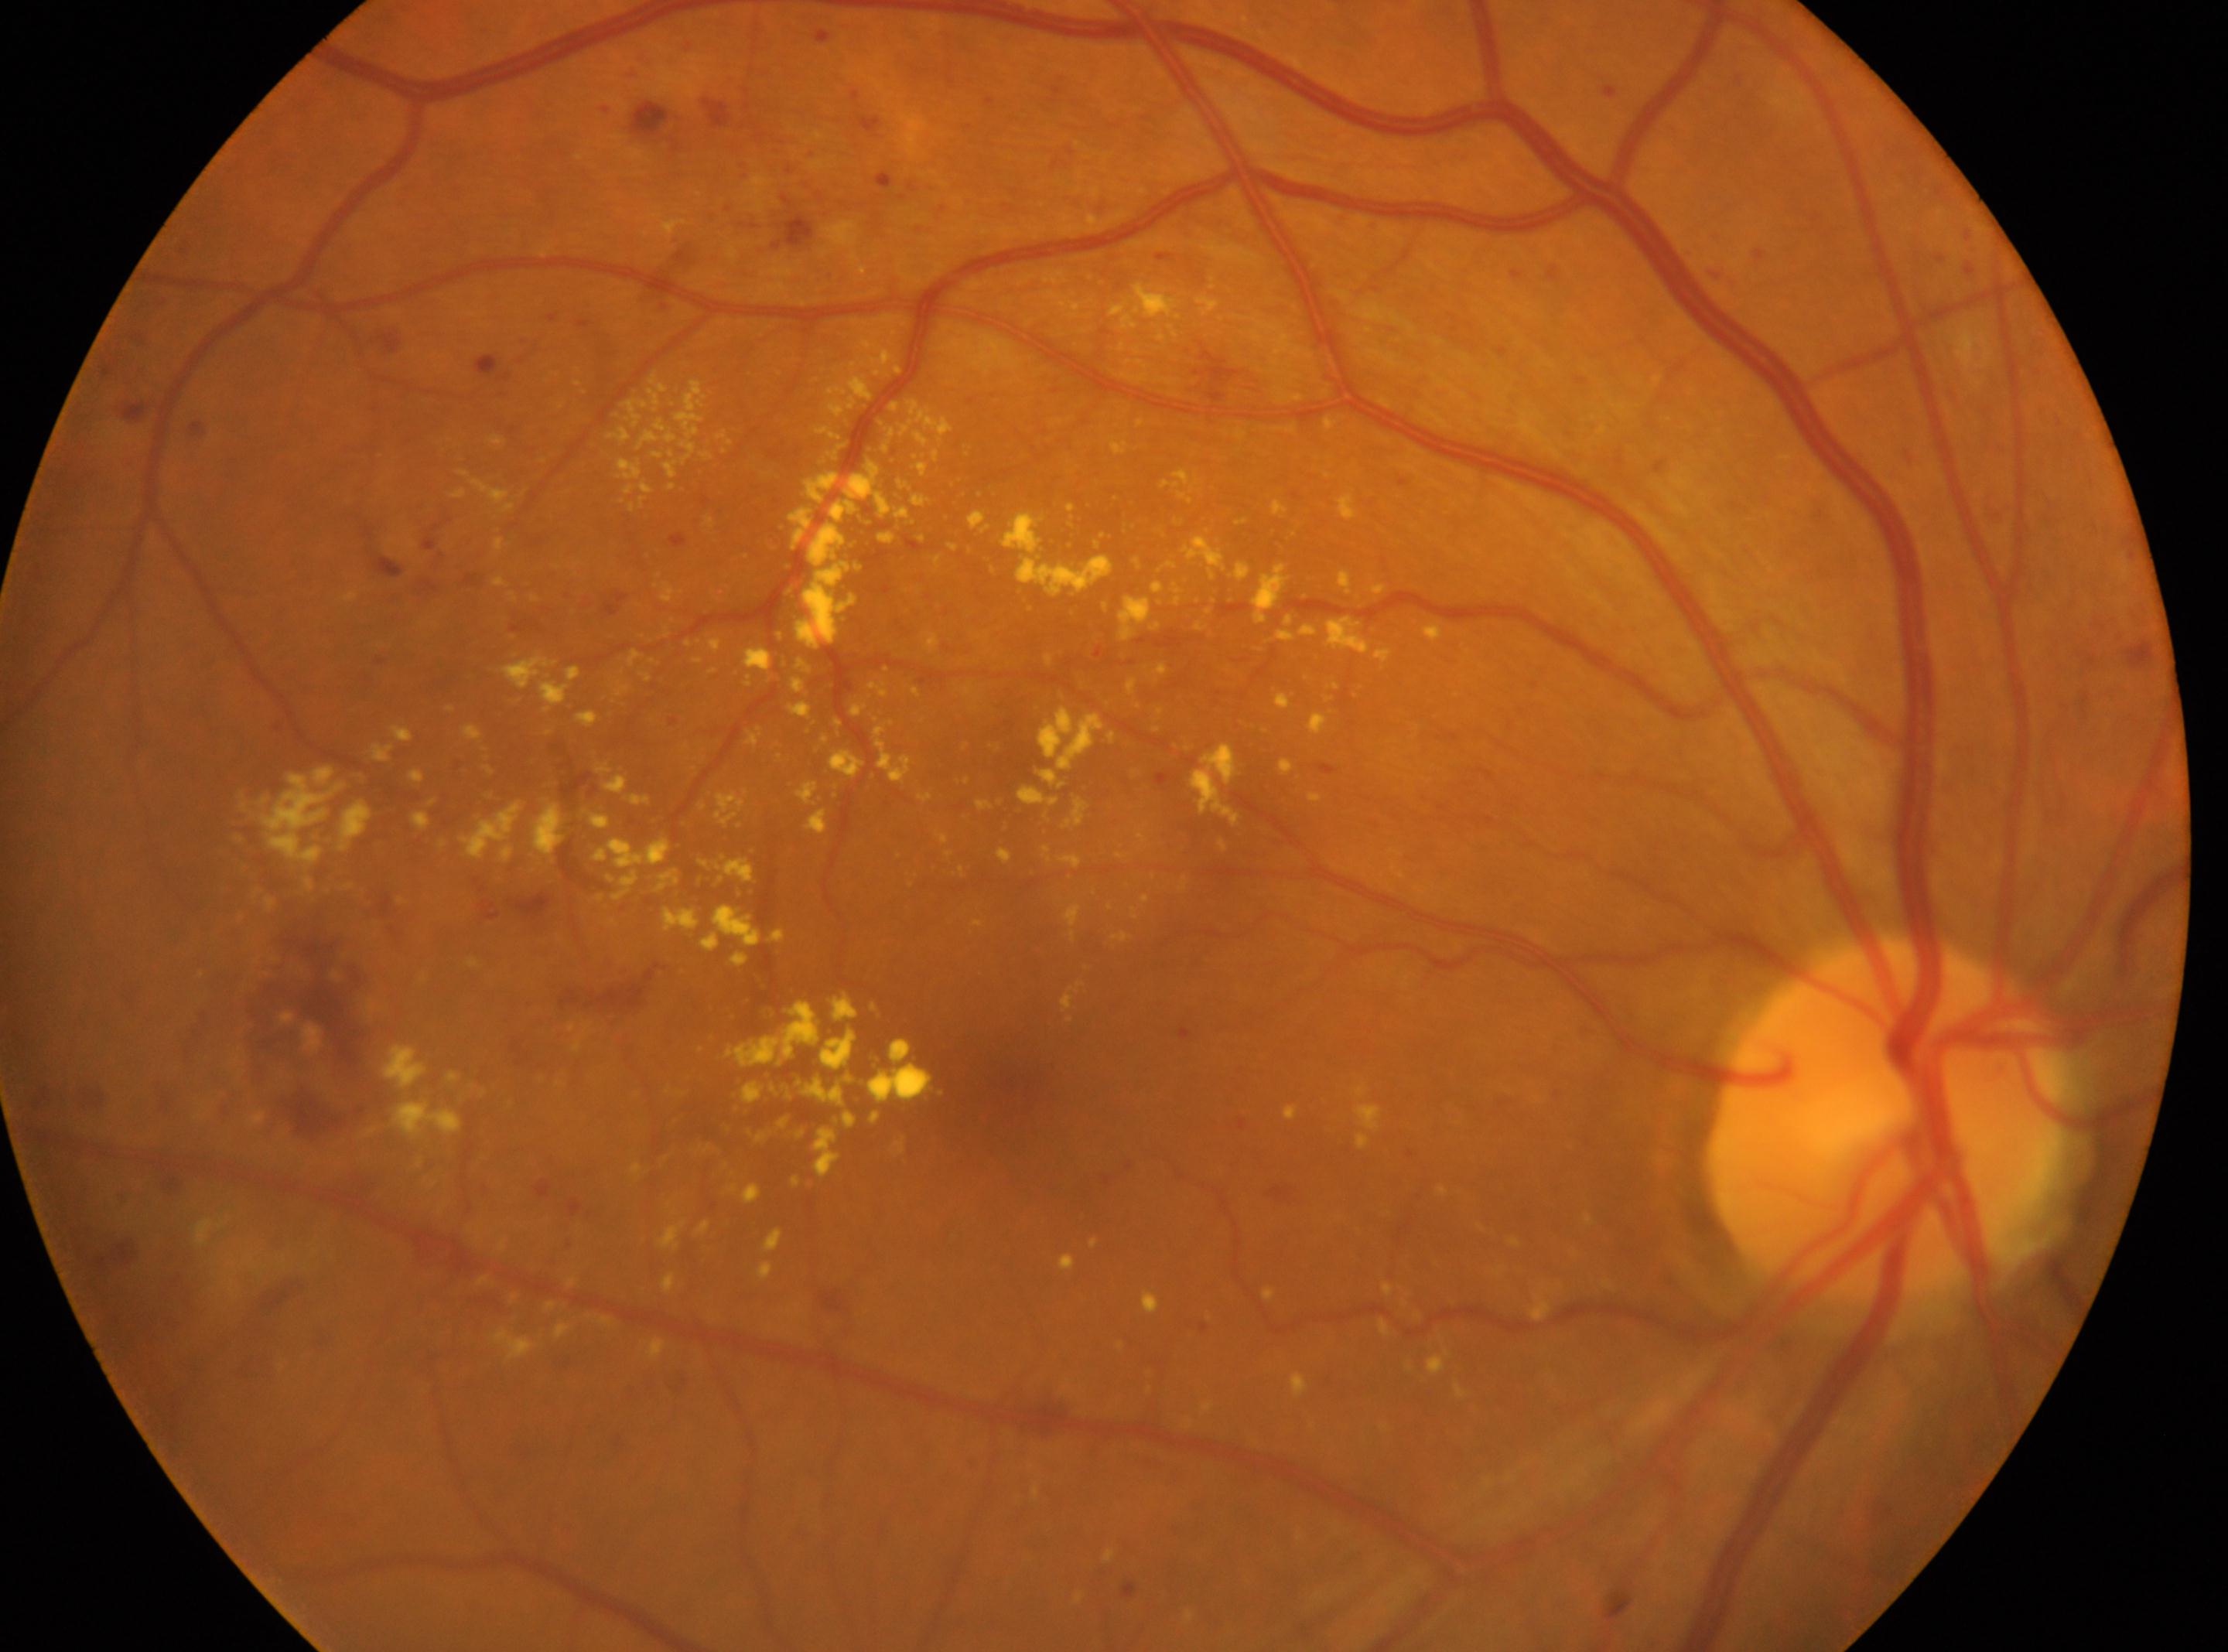
Diabetic retinopathy severity is grade 3 (severe NPDR).
Optic disc center located at (1886,1118).
Imaged eye: right.
The fovea is at (984,1086).
Disease class: non-proliferative diabetic retinopathy.